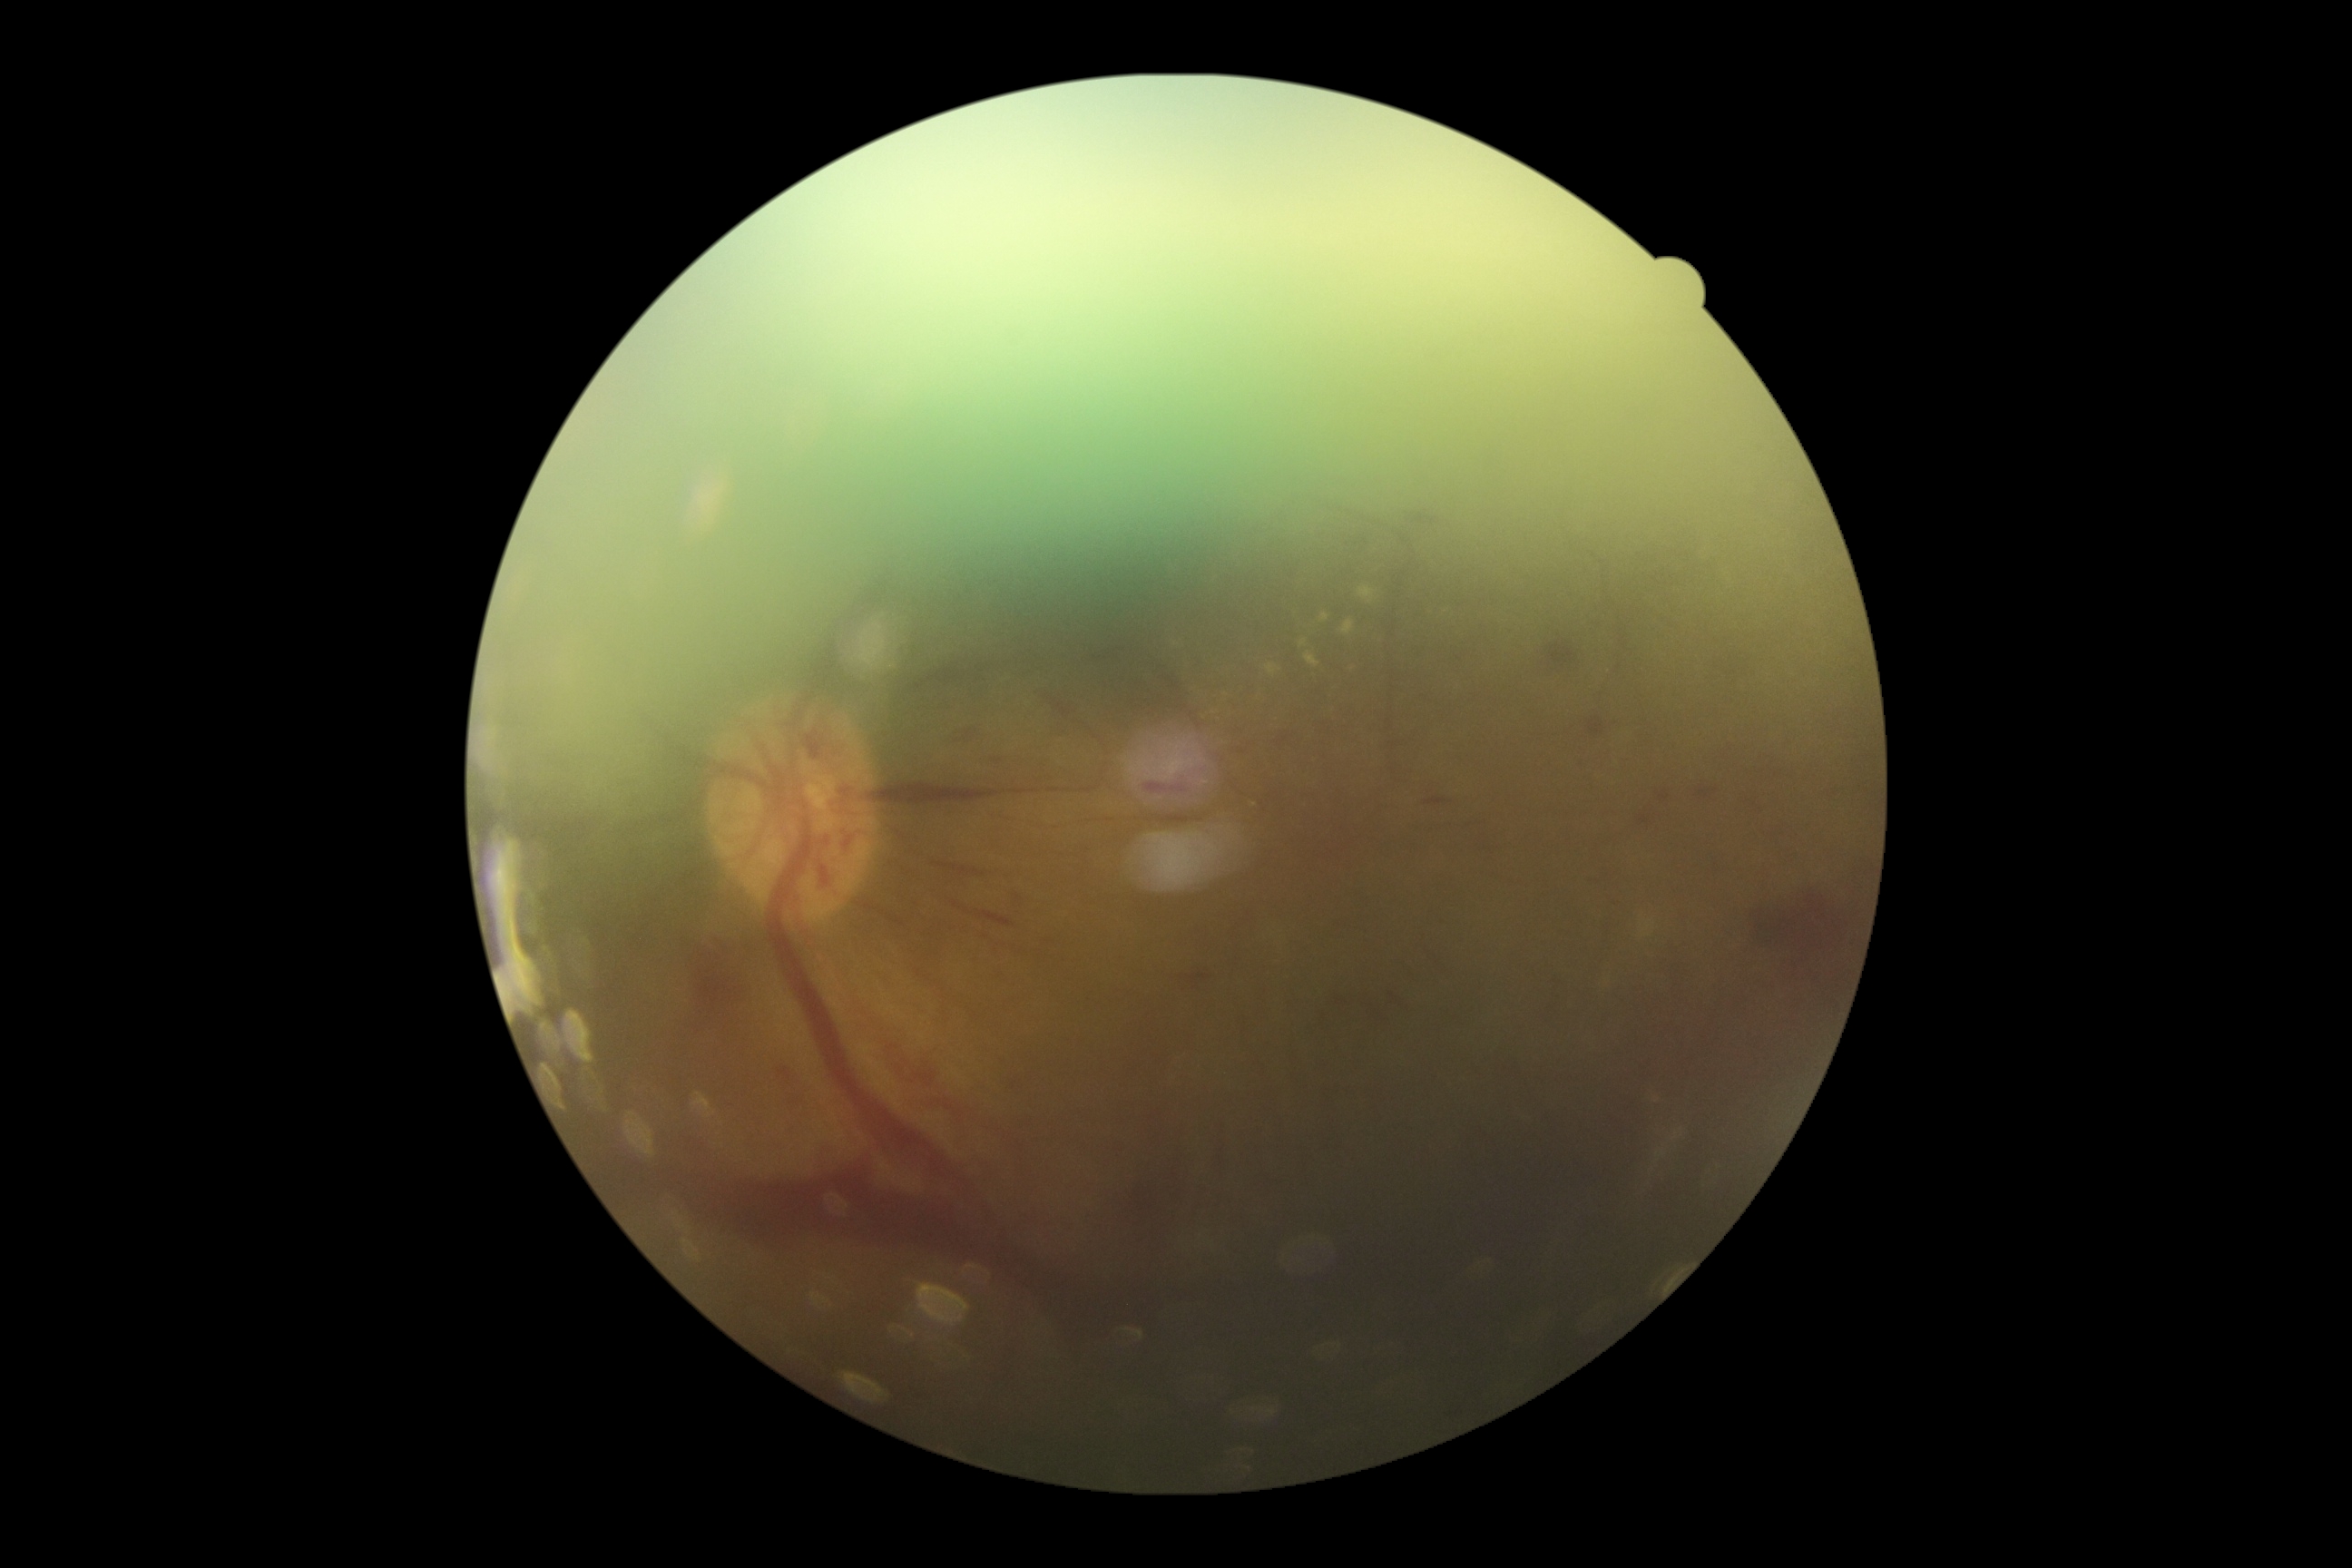
diabetic retinopathy (DR): grade 4 (PDR).